Modified Davis grading · FOV: 45 degrees · color fundus image · NIDEK AFC-230 fundus camera
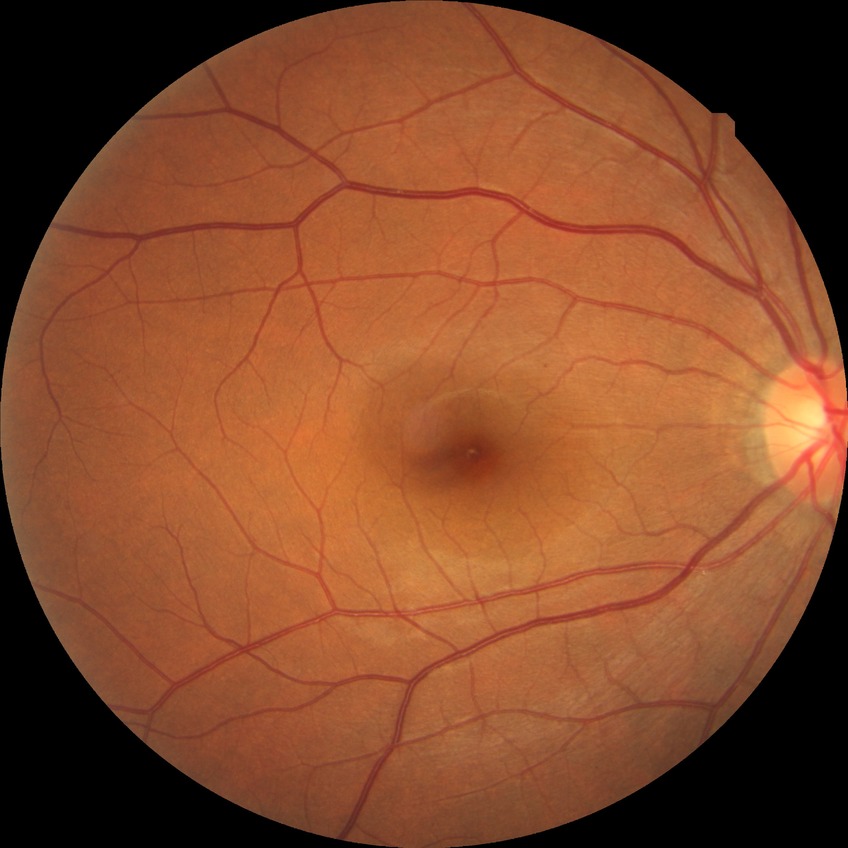
Diabetic retinopathy (DR): no diabetic retinopathy (NDR).